Posterior pole color fundus photograph:
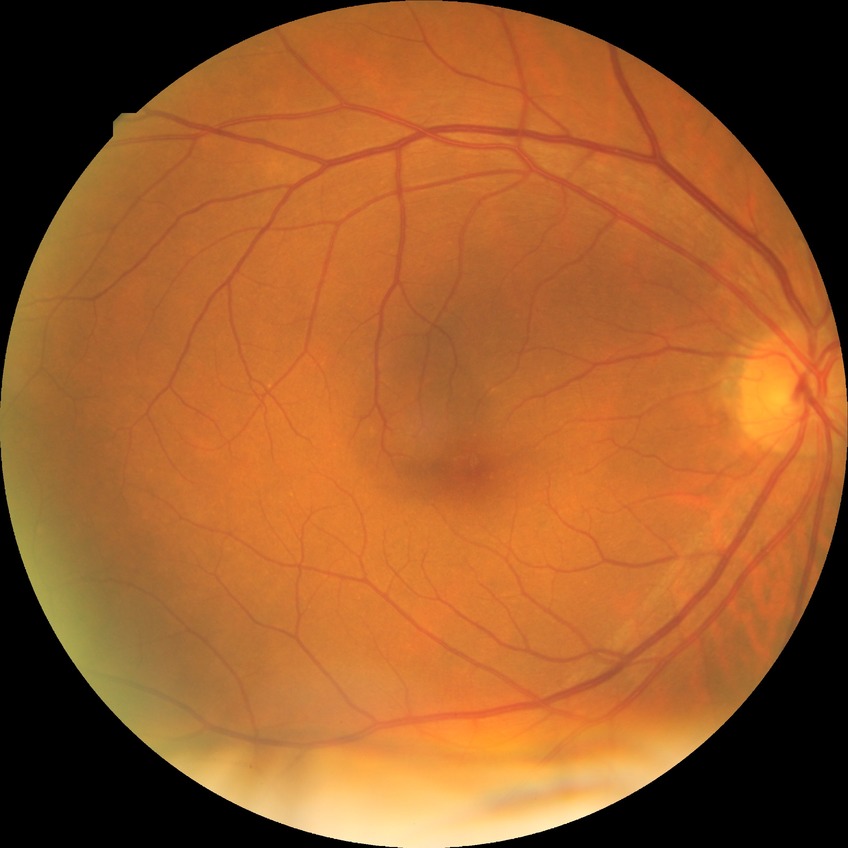 No diabetic retinal disease findings. DR: NDR.